Color fundus photograph
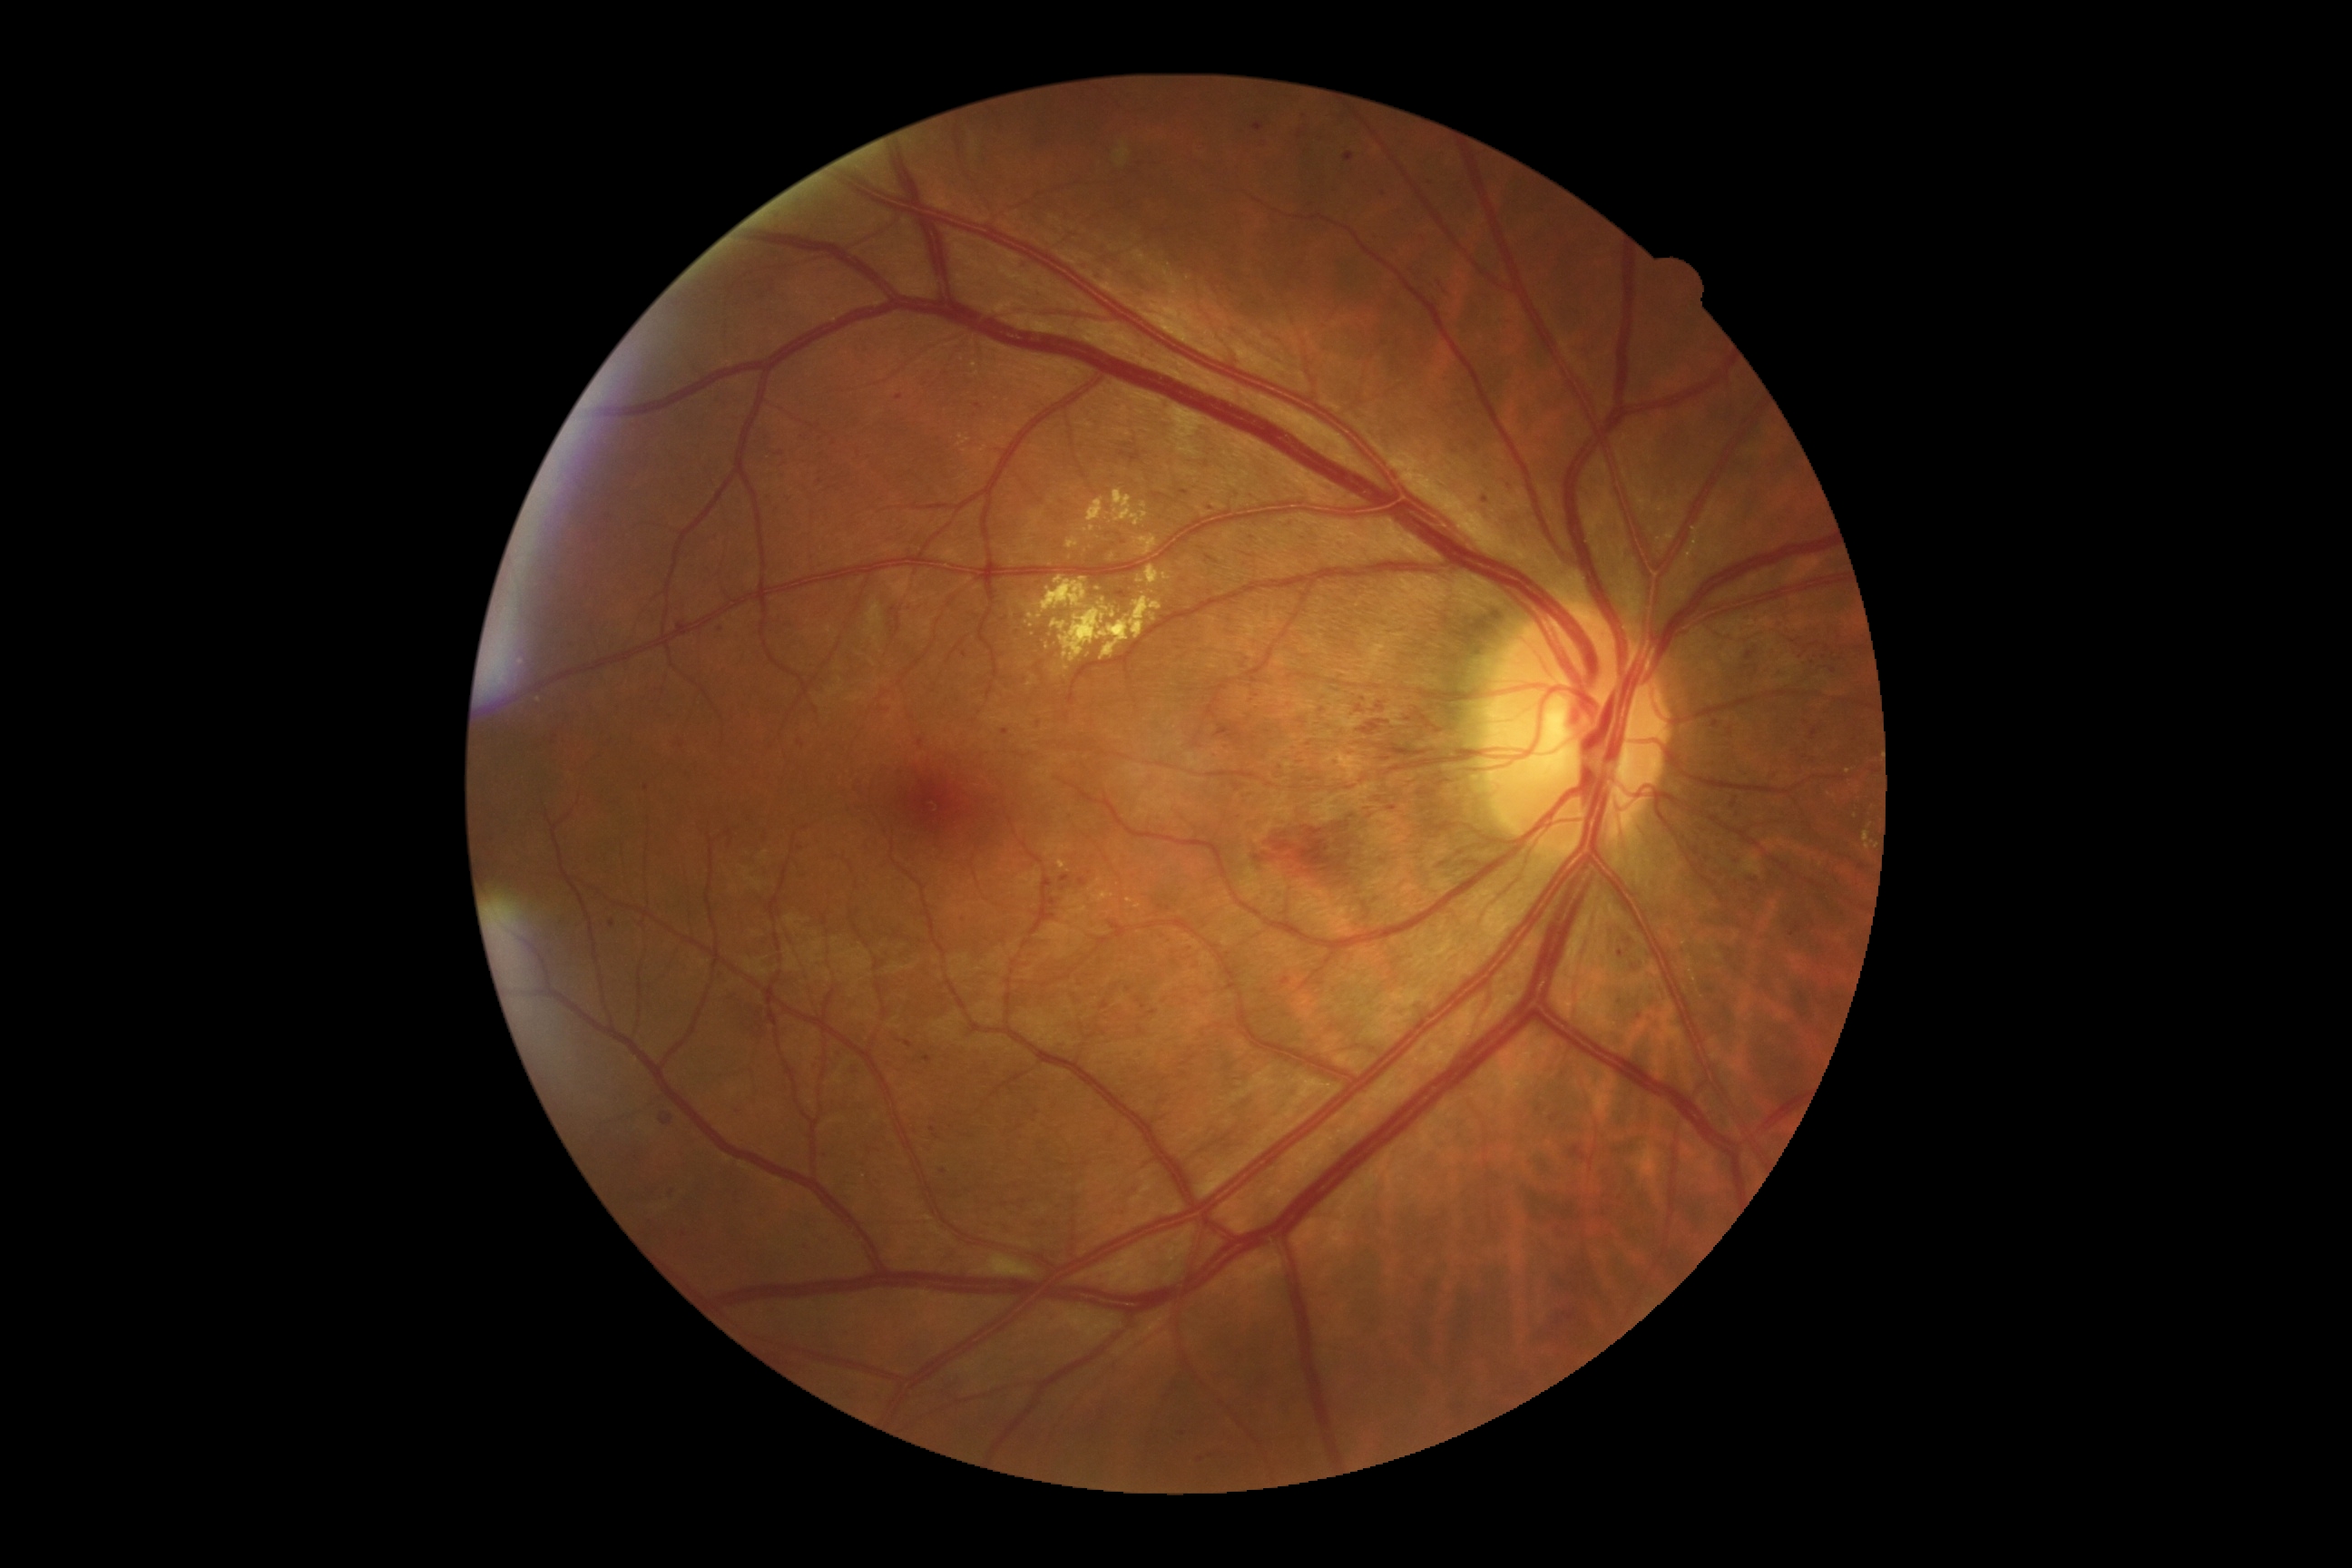

{"partial":true,"dr_grade":3,"dr_grade_name":"severe NPDR","lesions":{"he":[[1179,489,1190,498],[1482,496,1489,504],[1730,852,1747,867],[1253,122,1266,132],[1435,277,1451,297],[756,295,765,302],[716,970,730,983],[582,856,596,865],[1079,879,1088,888],[1547,1113,1560,1126],[1259,144,1269,150],[1061,876,1070,883],[1565,1146,1594,1170]],"he_small_approx":[[685,1235],[943,1171],[1267,732],[899,397],[682,746]]}}